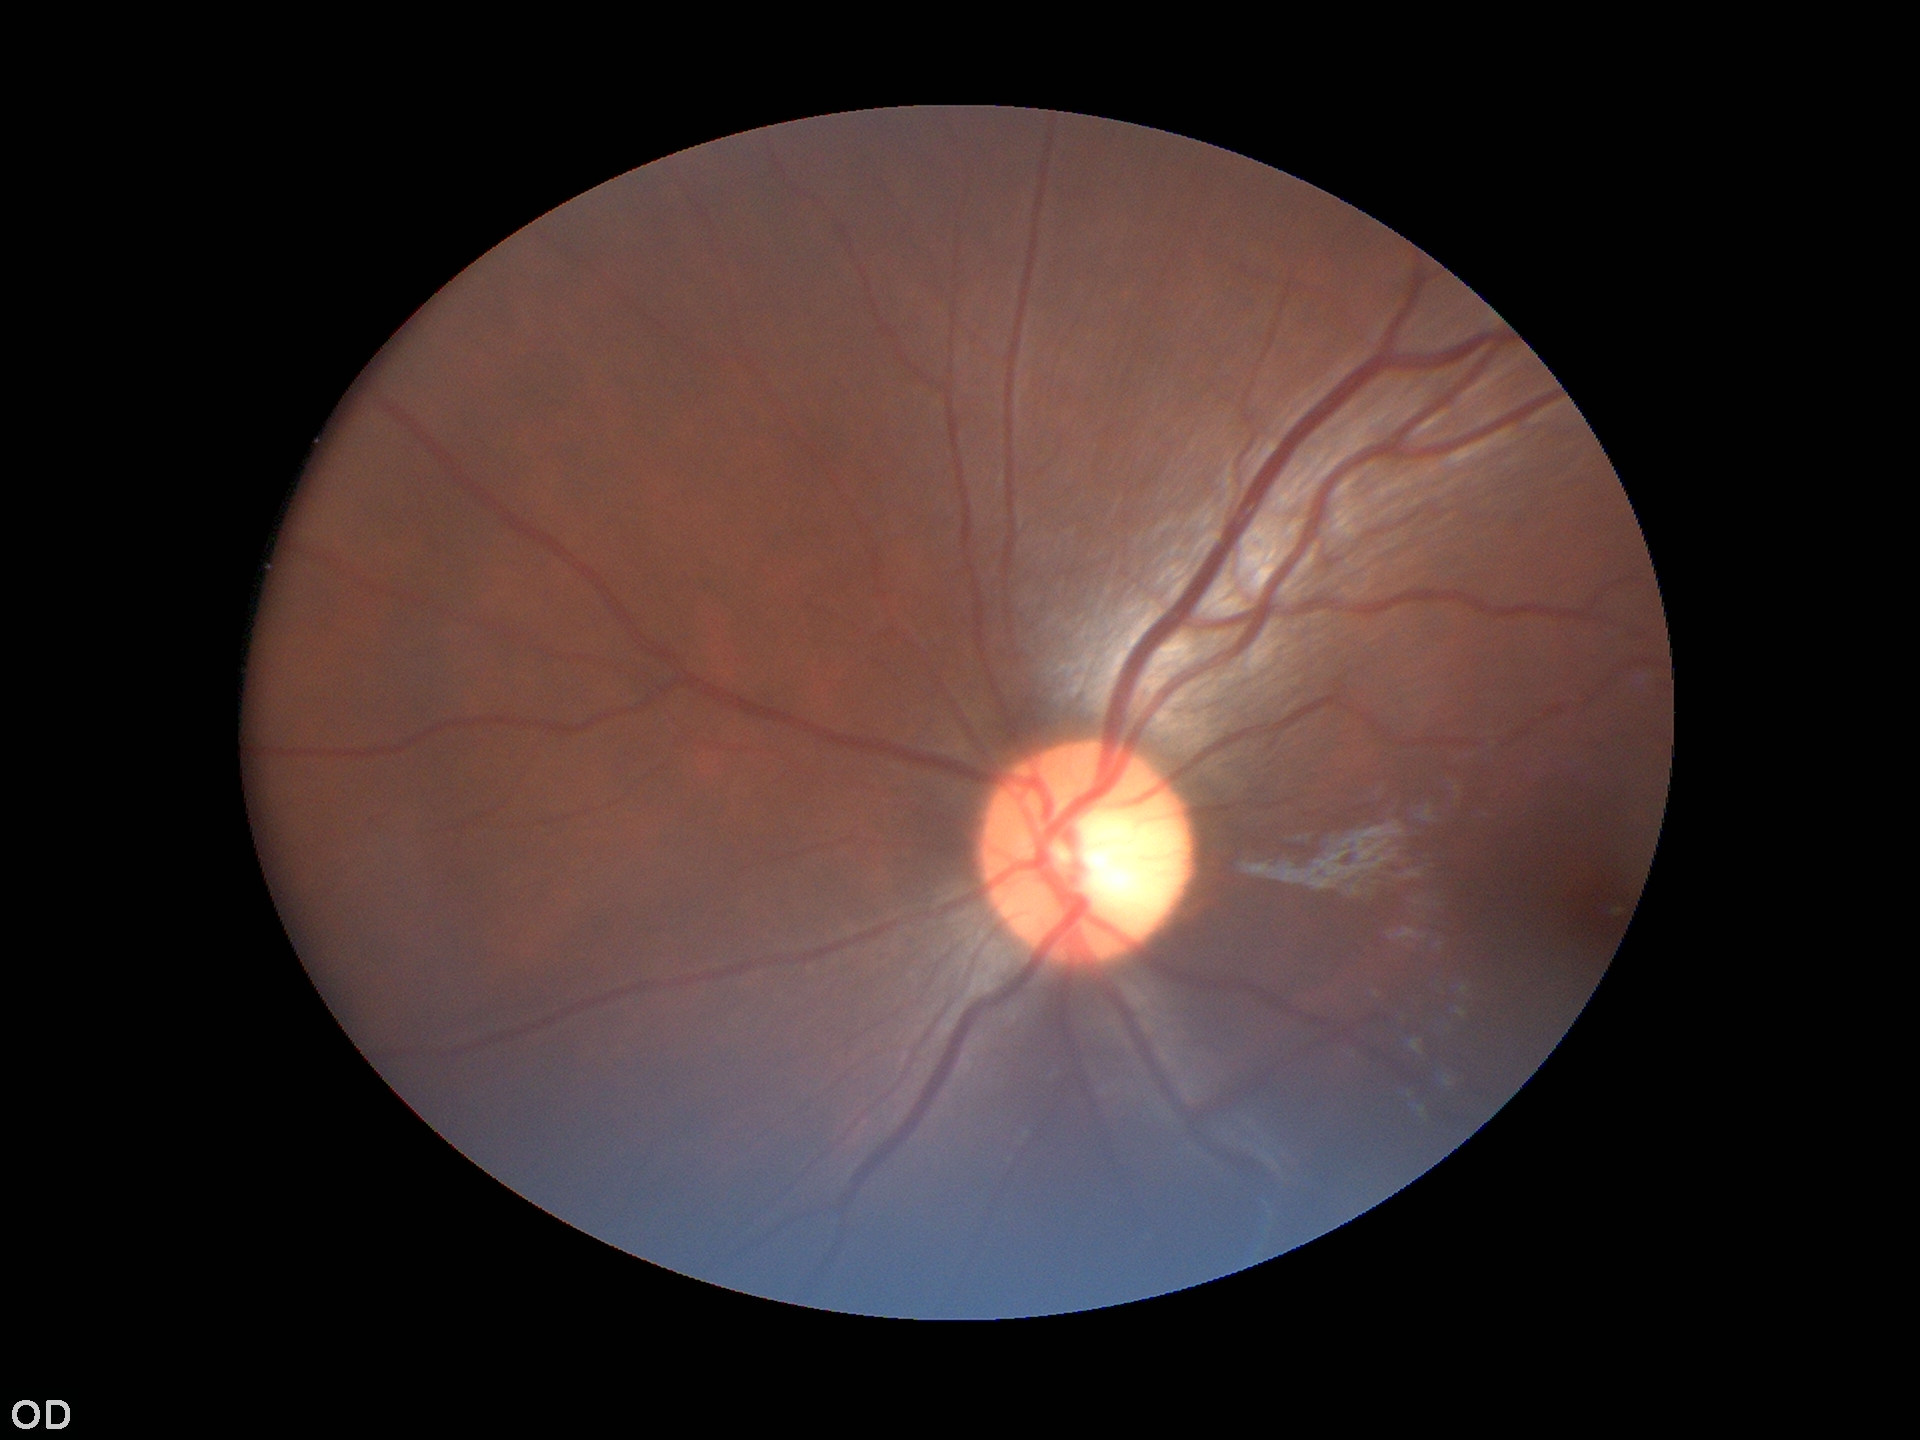

Annotations:
• Glaucoma decision: not suspect
• vertical C/D ratio (VCDR): 0.50